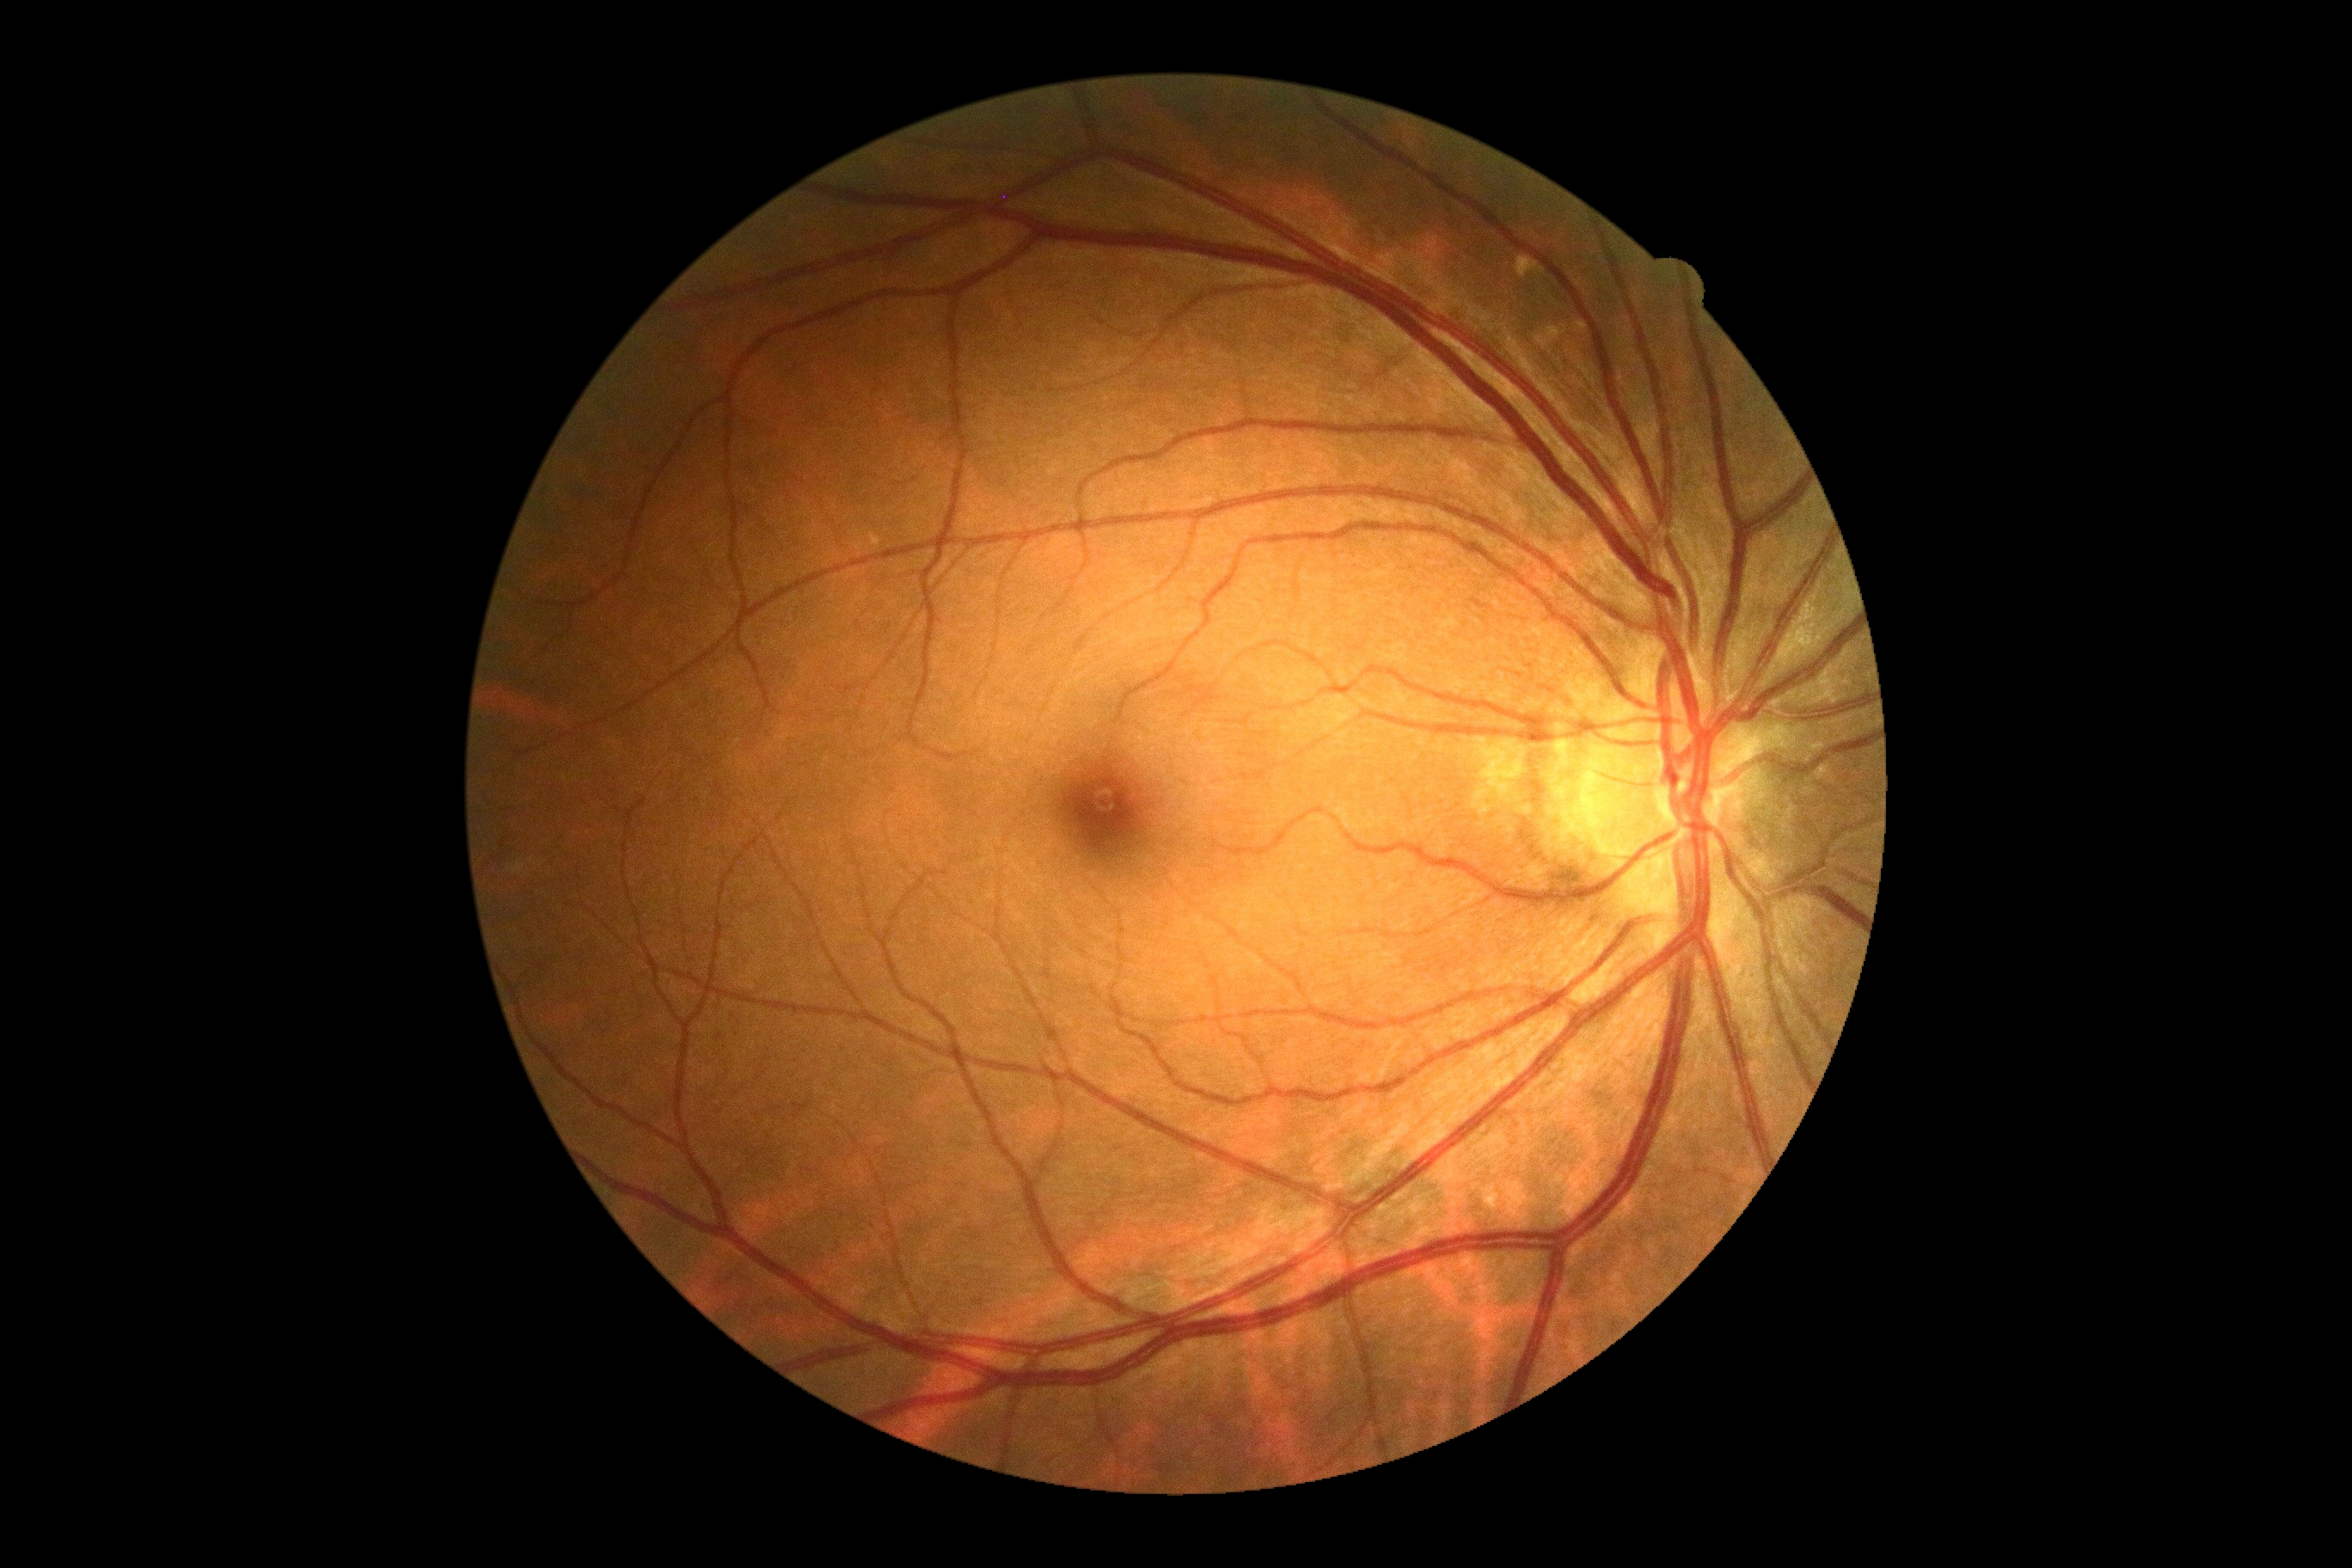

dr_impression: negative for DR
dr_grade: grade 0 (no apparent retinopathy)